FOV: 45 degrees.
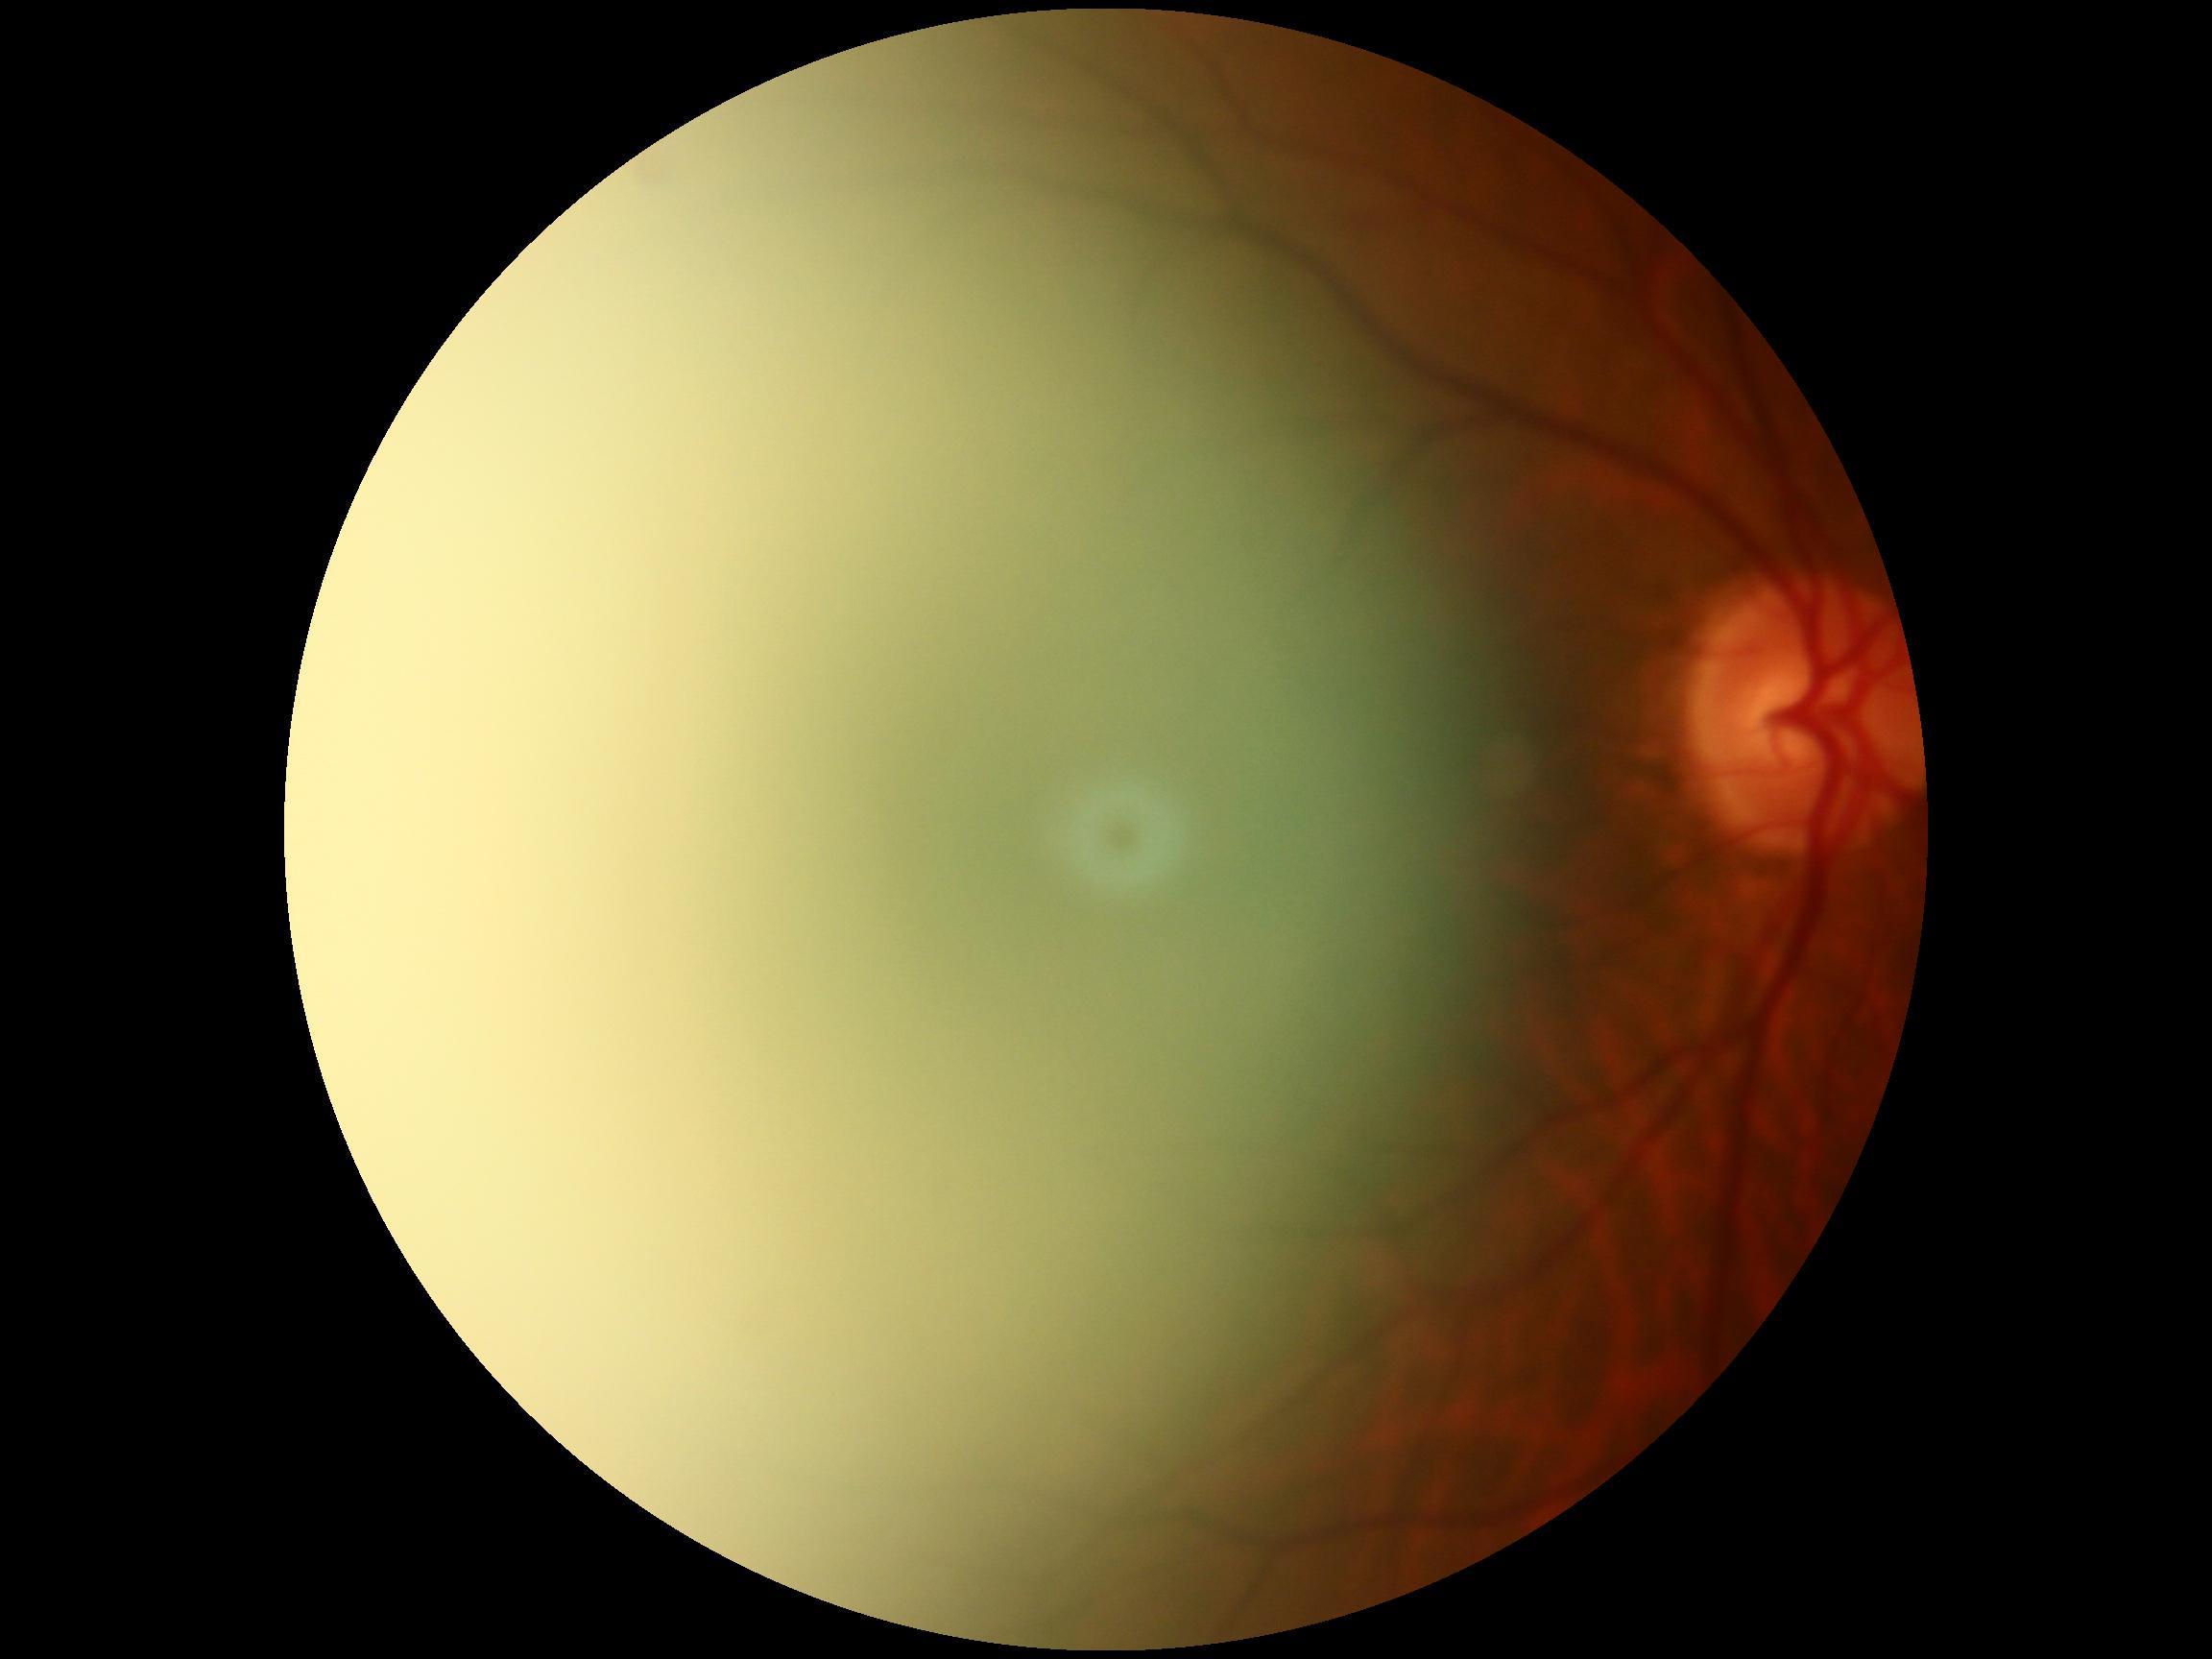
quality: too poor for DR grading
dr_grade: ungradable